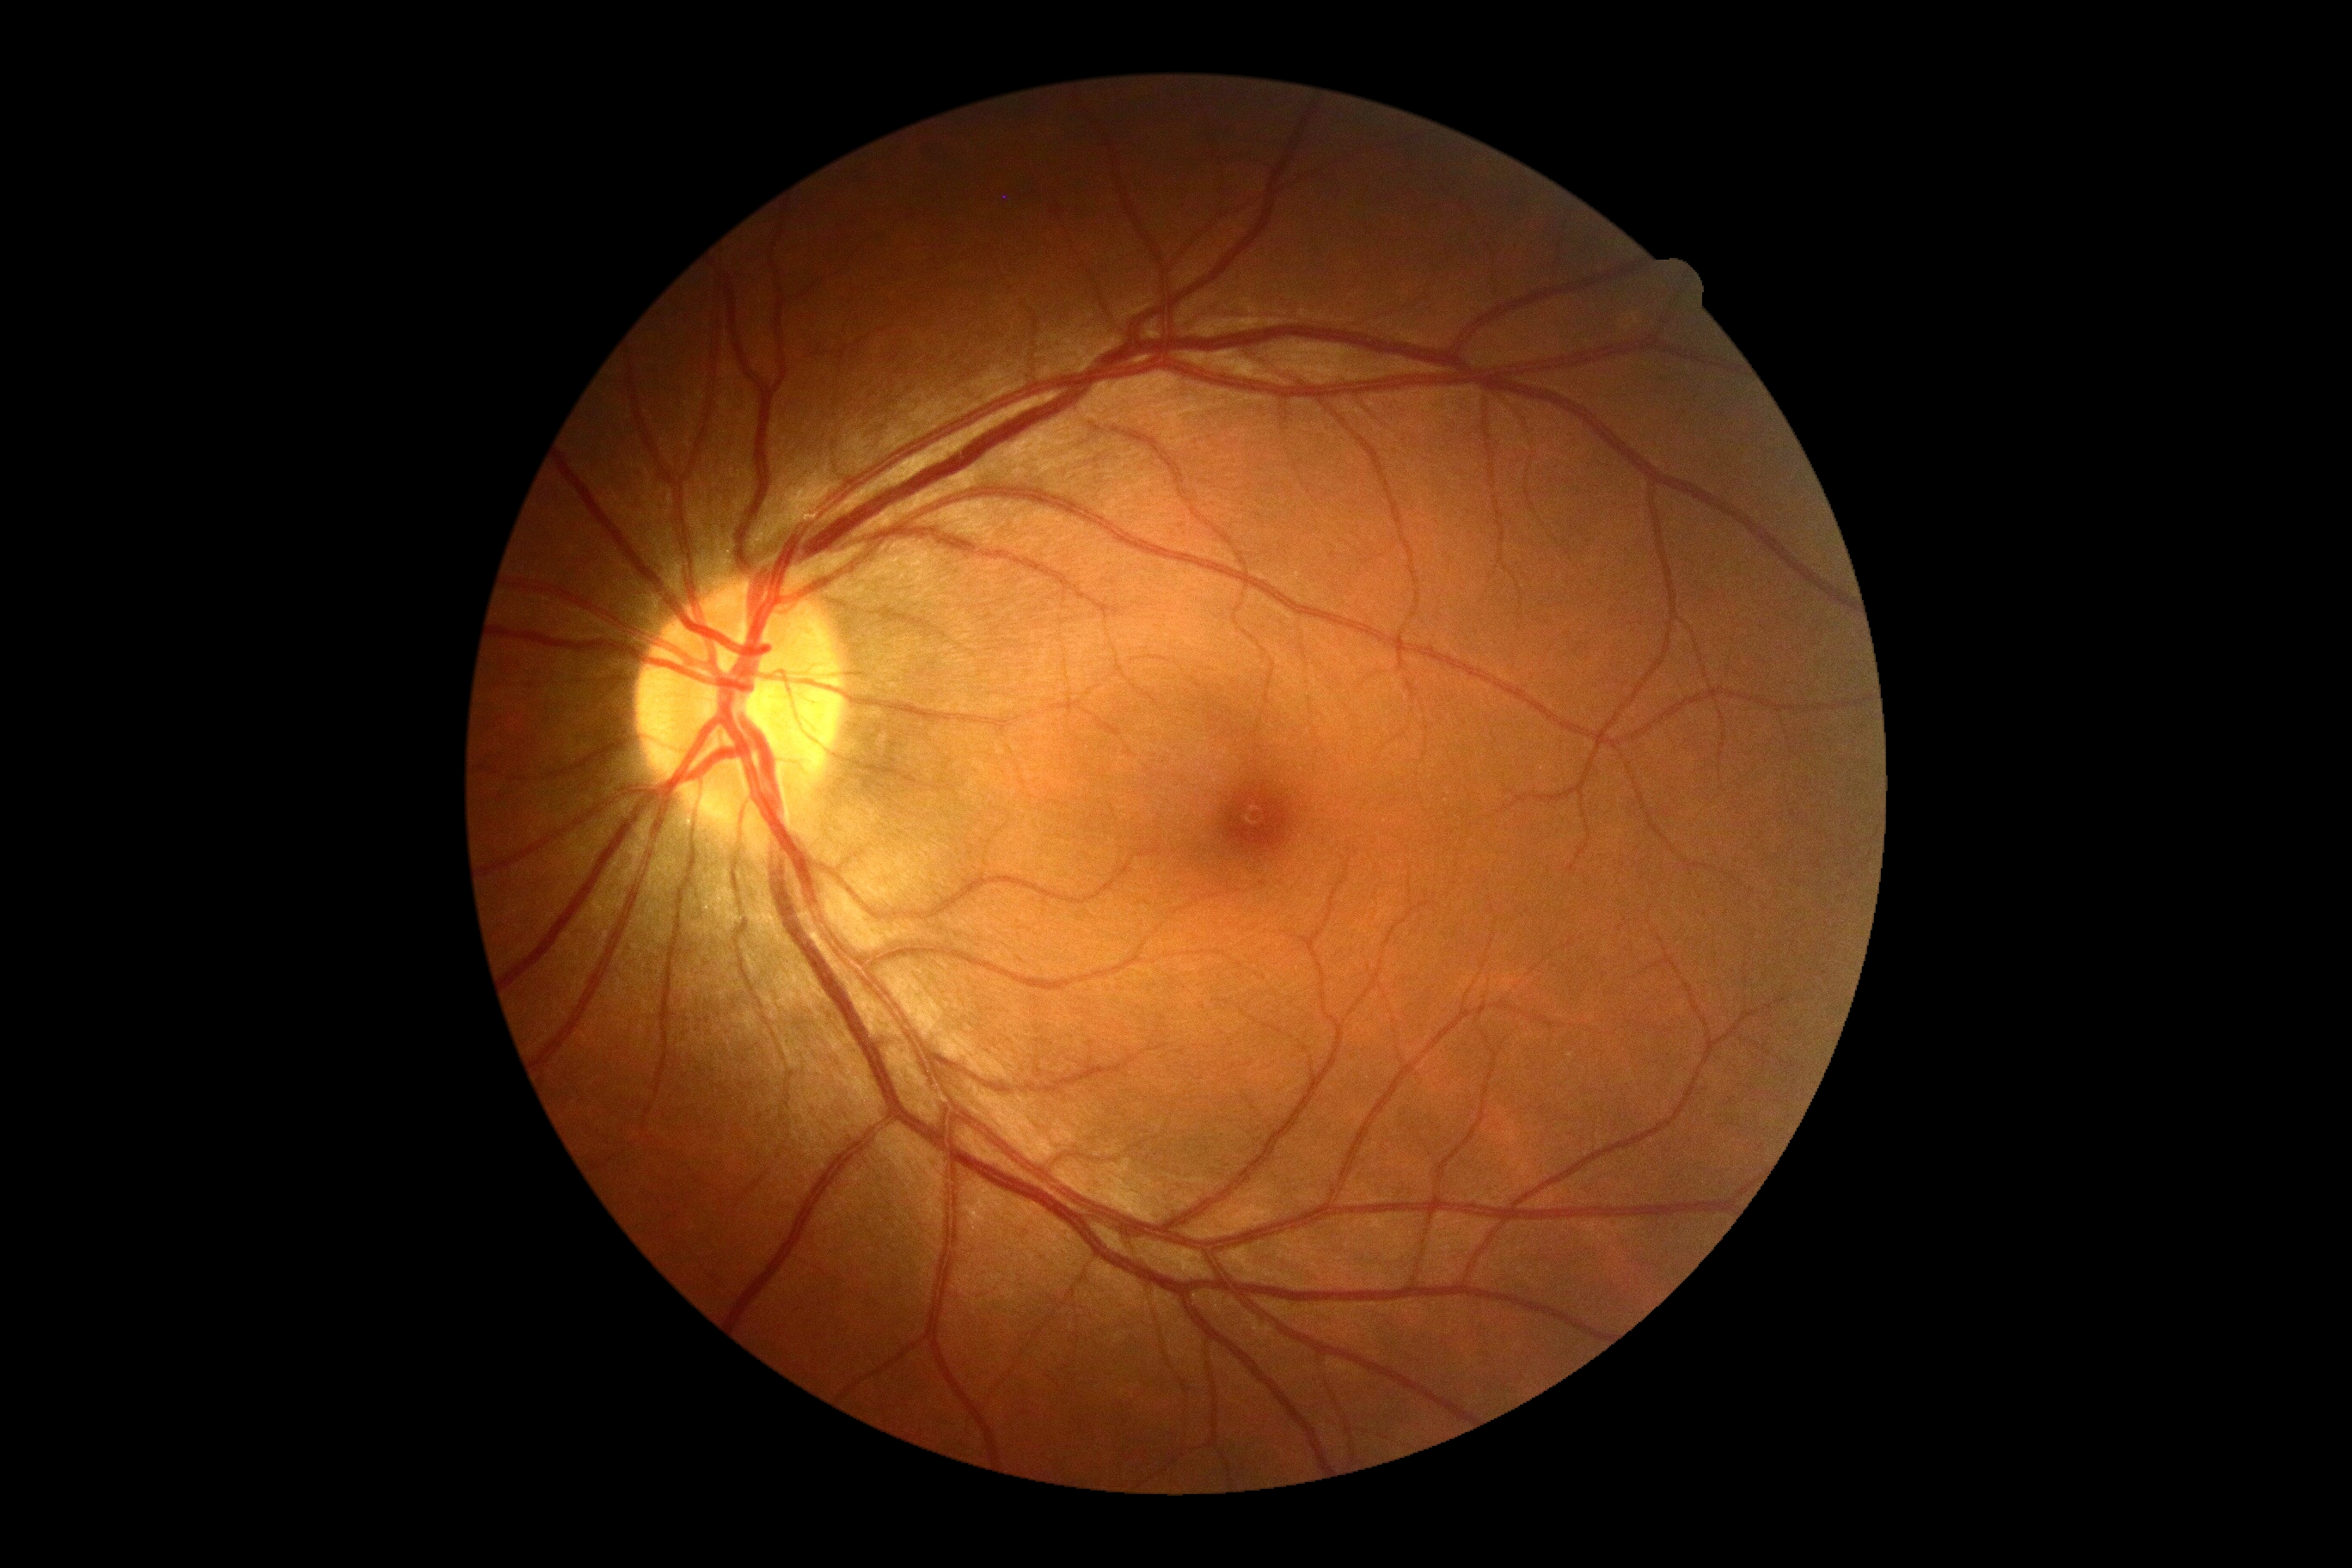

DR: grade 0 (no apparent retinopathy).